1932x1916px, CFP.
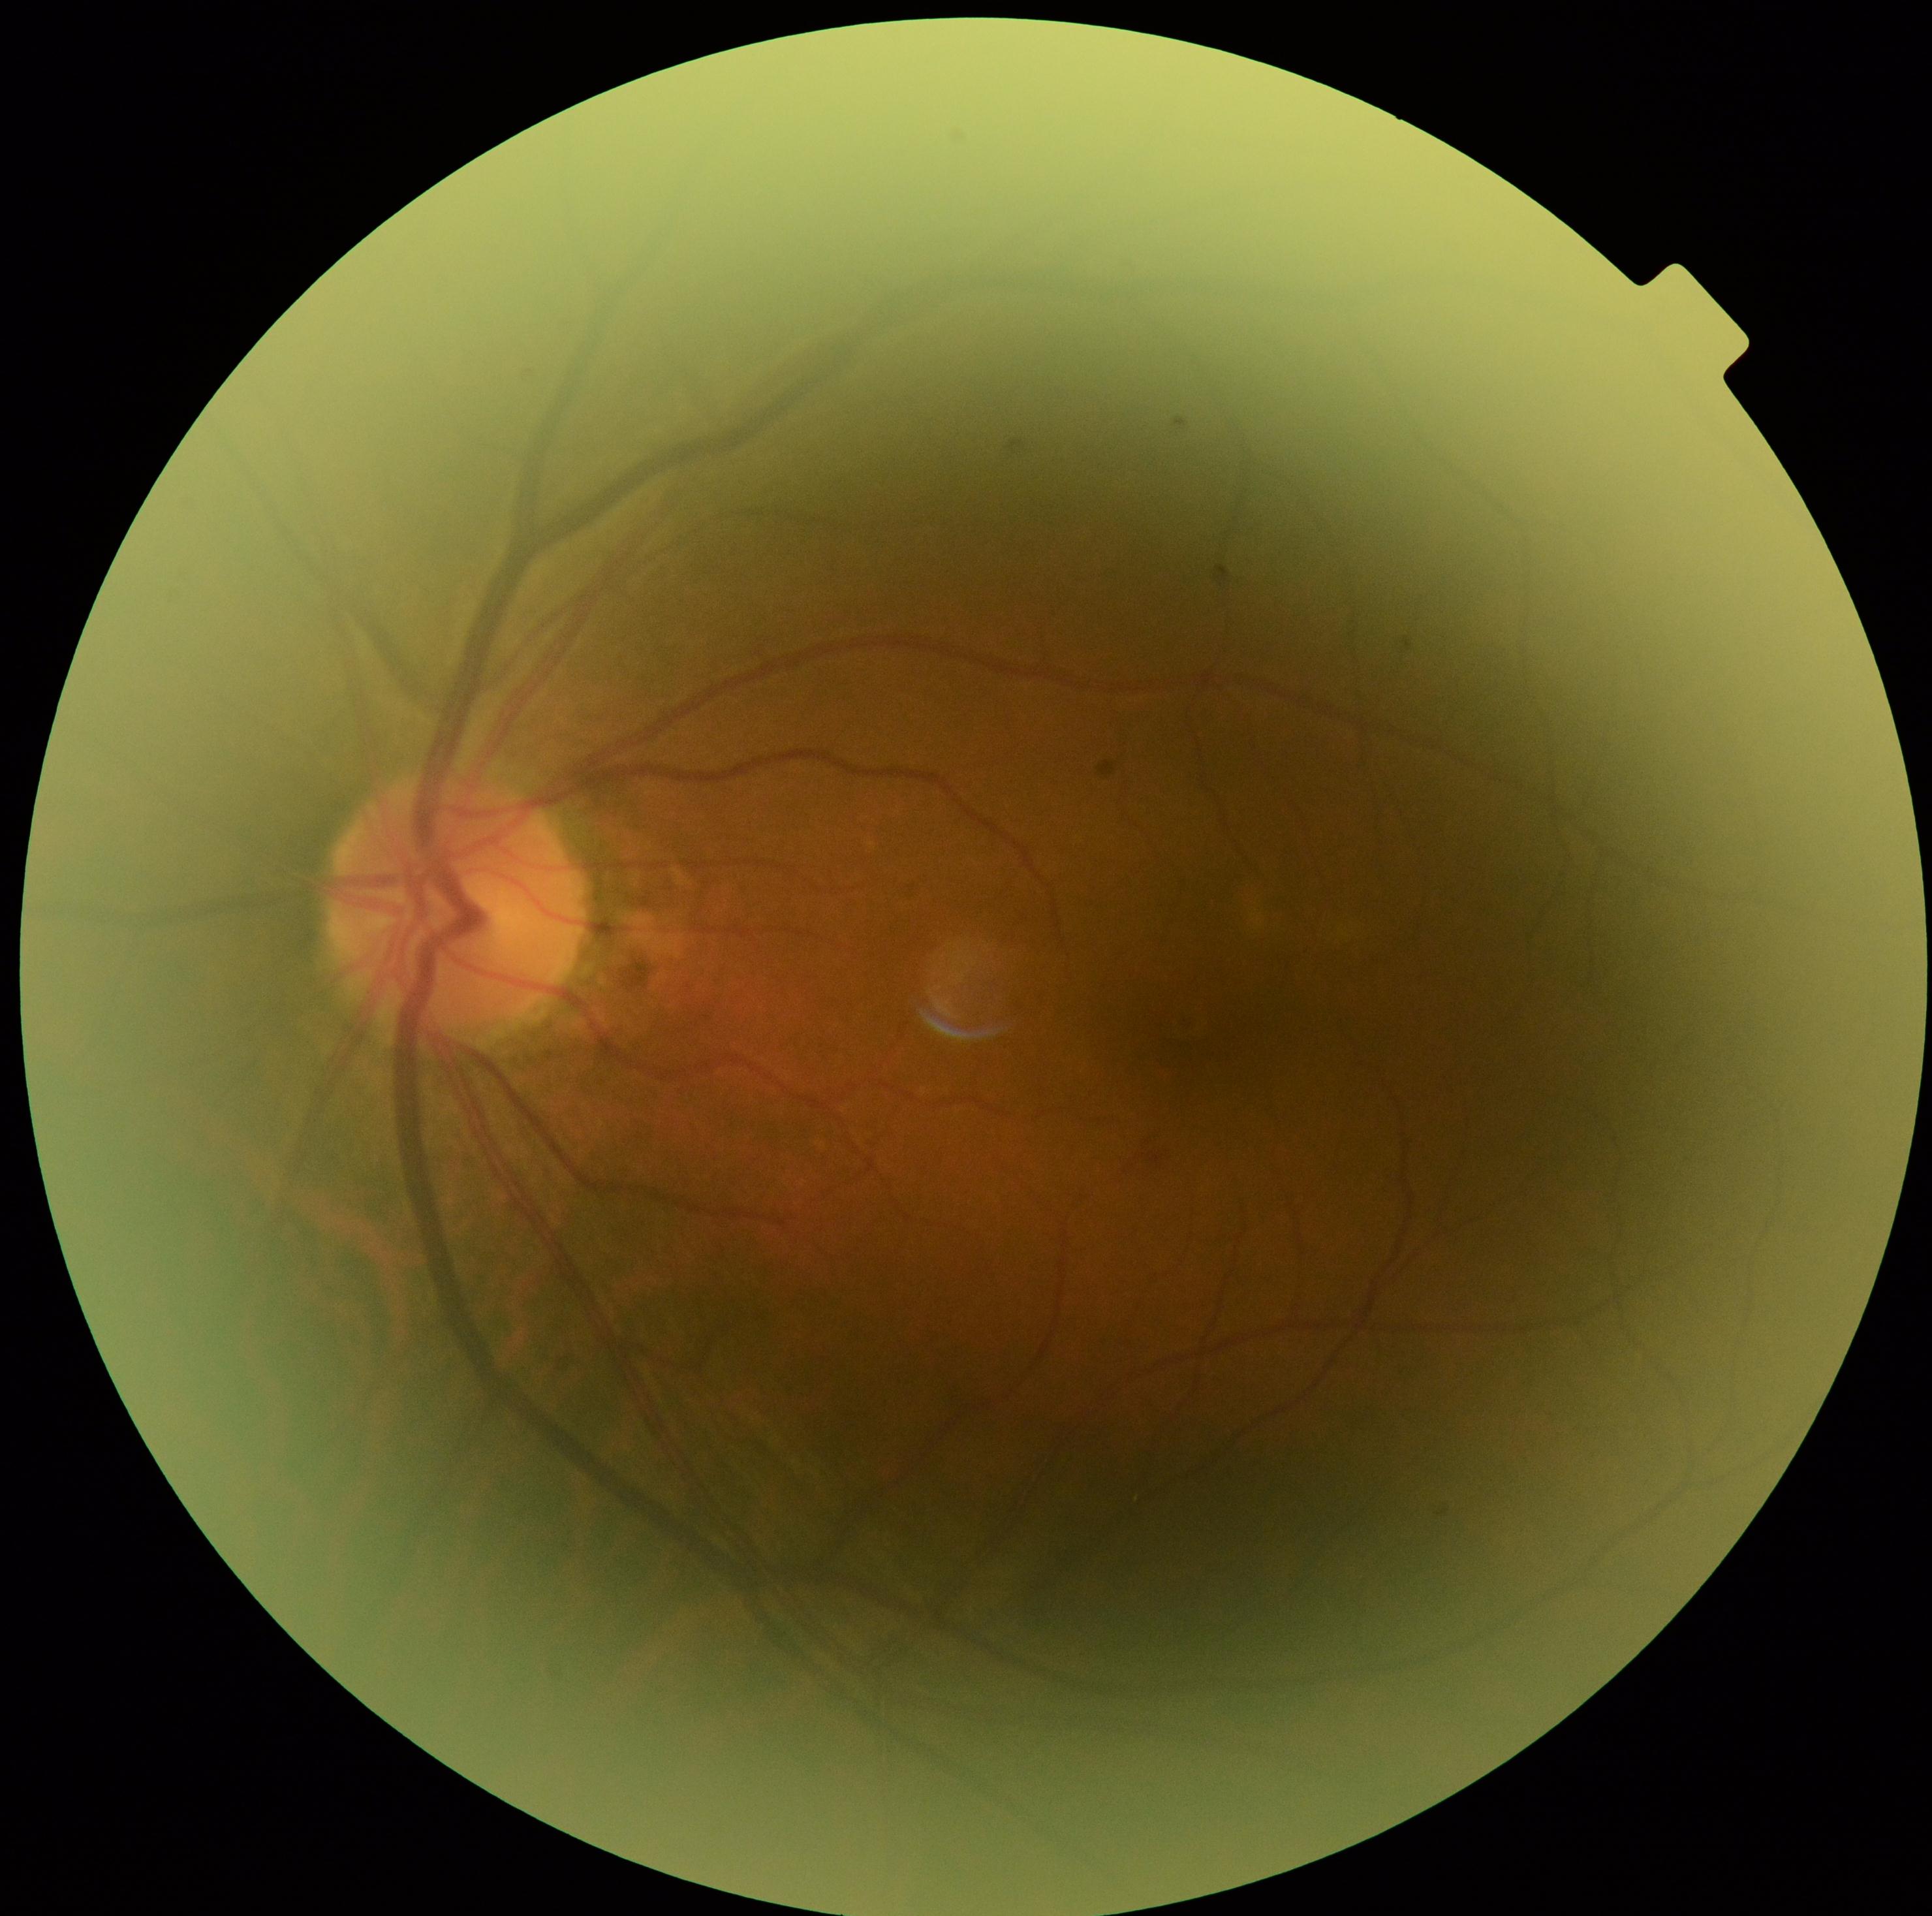
Diabetic retinopathy (DR) is grade 1 (mild NPDR).